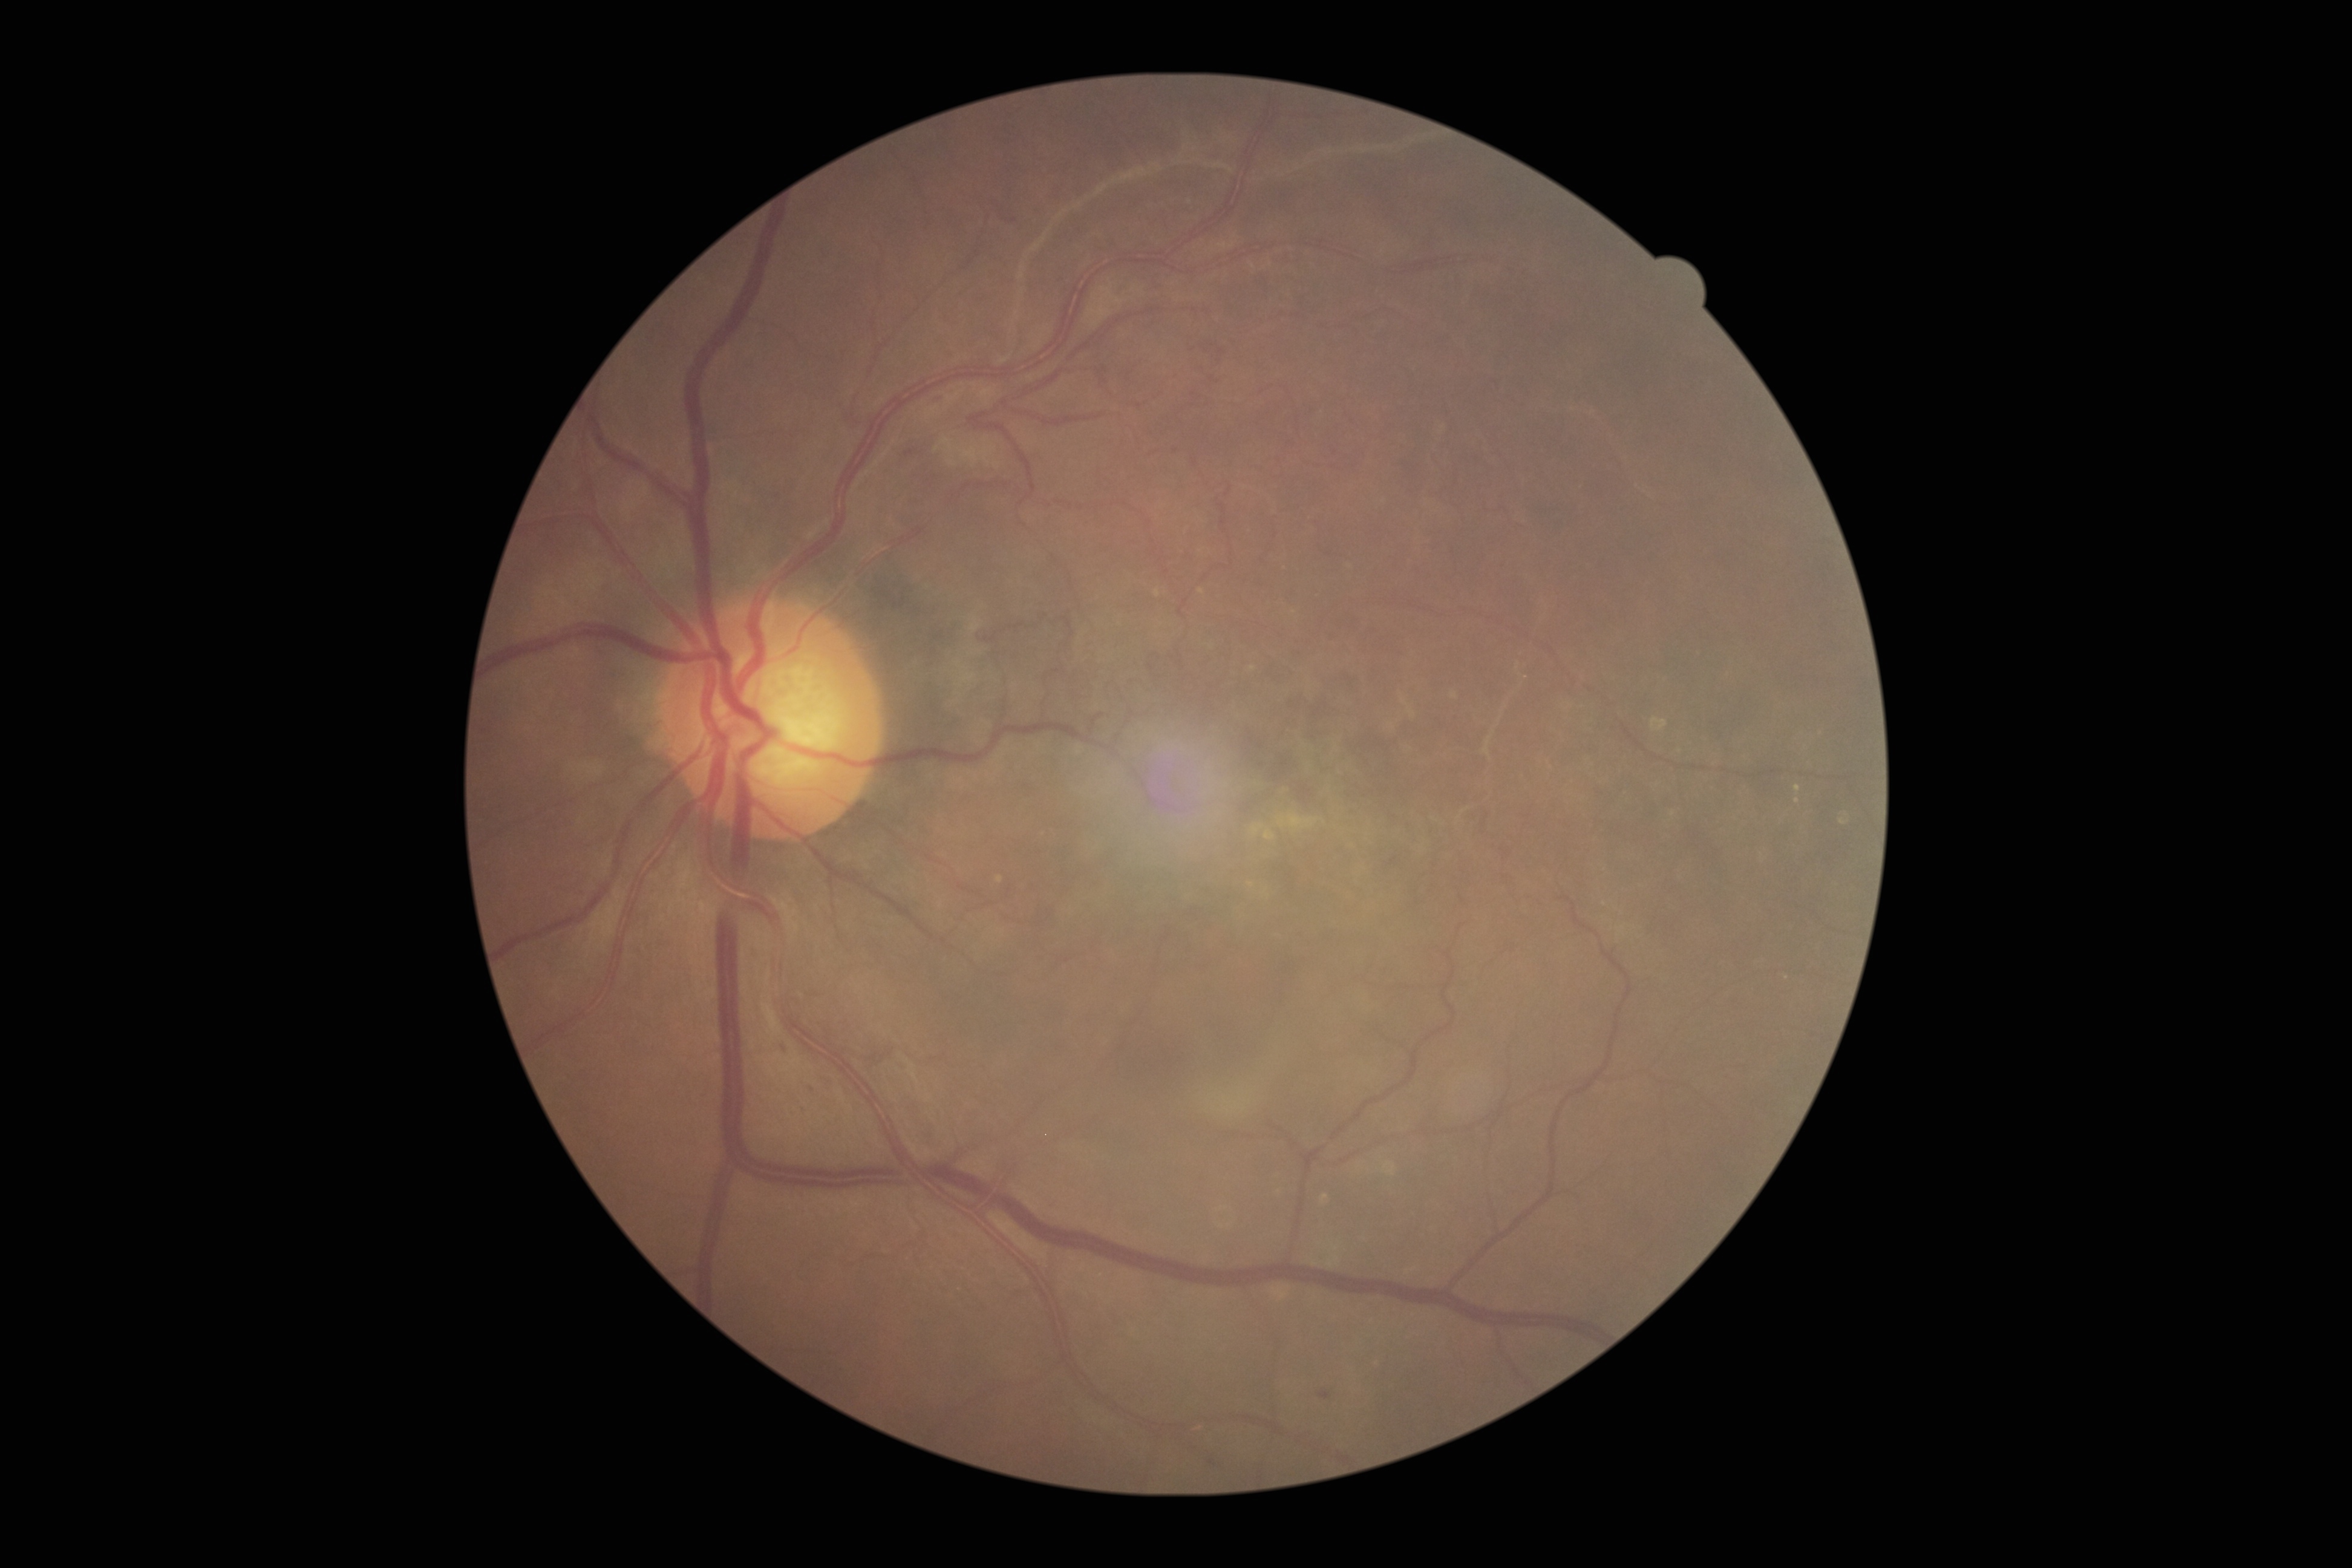
Diabetic retinopathy (DR) is 3/4.